Fundus photo
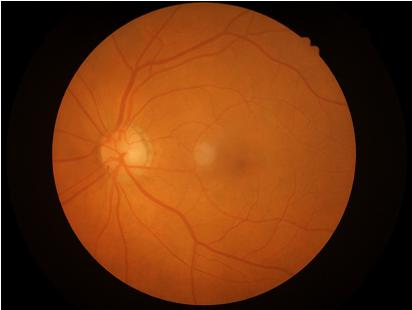
Illumination: even
Overall image quality: acceptable
Focus: in focus